Pediatric wide-field fundus photograph. Clarity RetCam 3, 130° FOV: 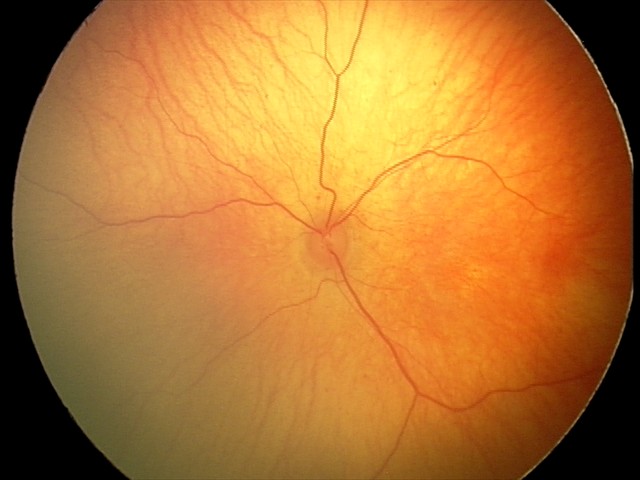
Screening examination diagnosed as physiological.